FOV: 45 degrees, color fundus image.
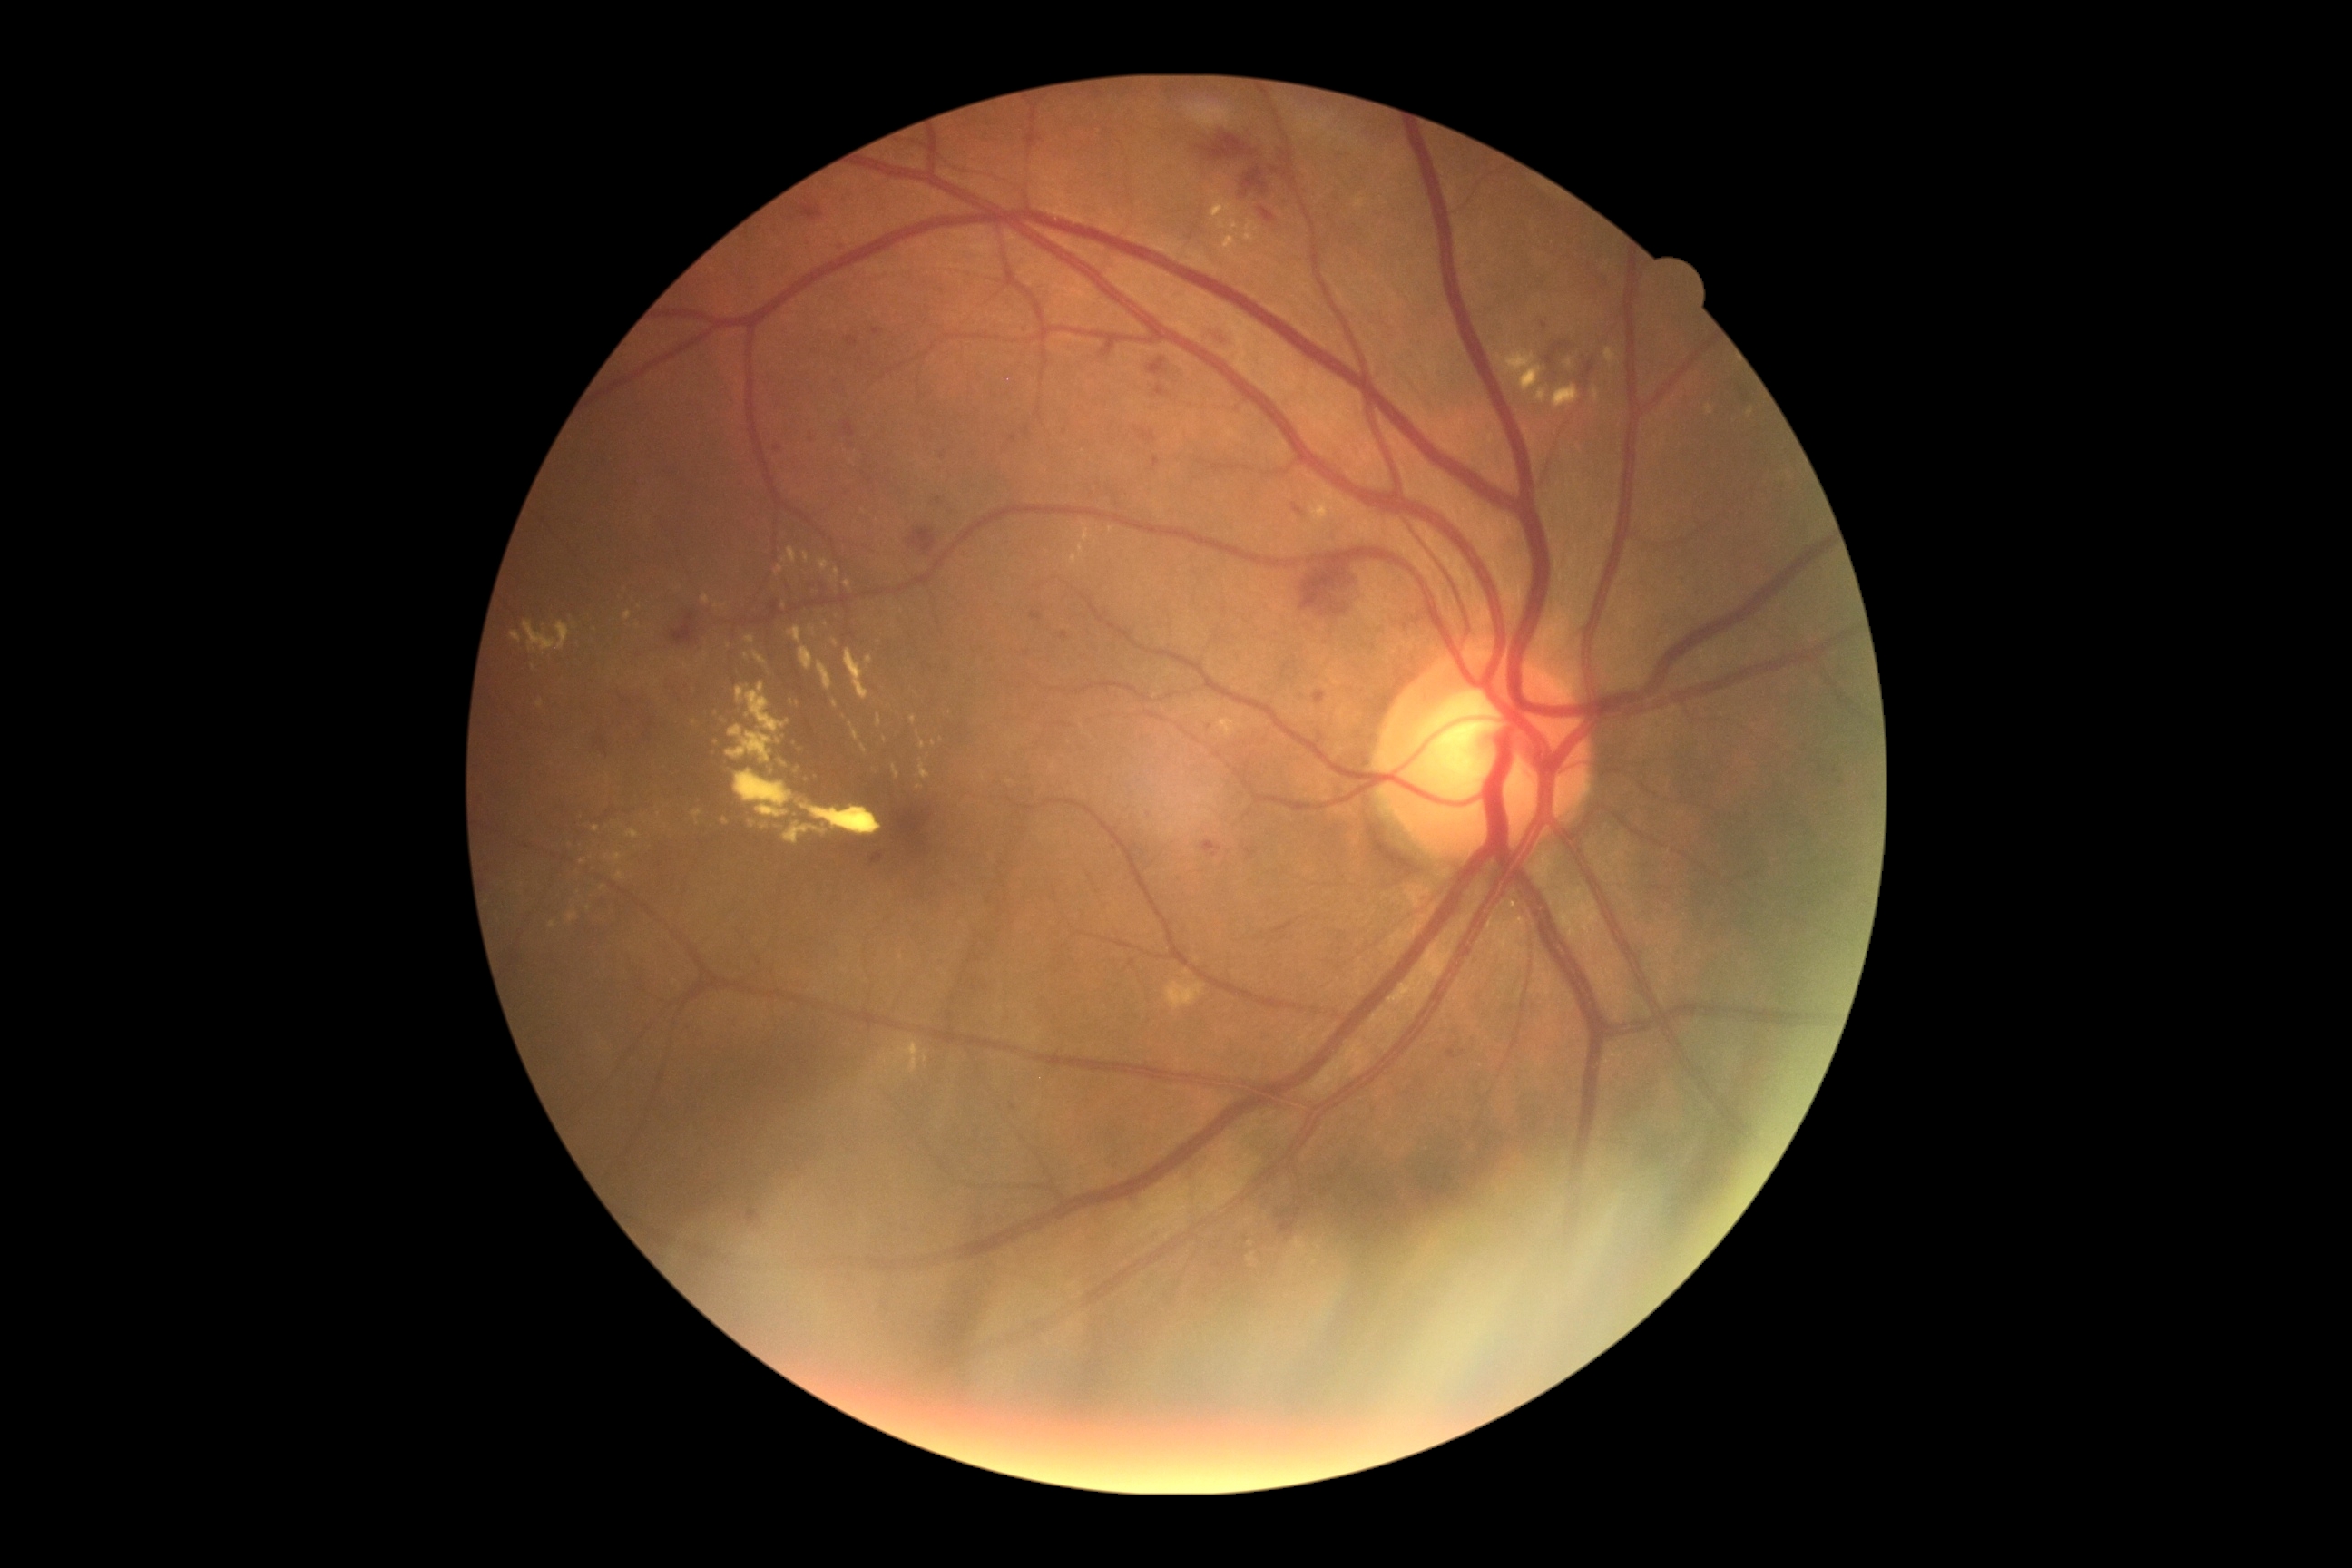 <lesions partial="true">
  <dr_grade>2</dr_grade>
  <se />
  <he partial="true">l=908, t=529, r=937, b=554, l=1135, t=429, r=1157, b=444, l=1277, t=1211, r=1286, b=1219, l=1280, t=1220, r=1297, b=1233, l=671, t=614, r=696, b=647, l=772, t=602, r=783, b=618, l=1295, t=560, r=1357, b=616, l=747, t=1210, r=761, b=1222, l=1208, t=331, r=1235, b=346, l=847, t=440, r=854, b=451, l=1293, t=505, r=1304, b=516, l=1202, t=841, r=1222, b=859, l=1155, t=387, r=1170, b=397</he>
  <he_small_centers>(x=1283, y=155)</he_small_centers>
  <ex partial="true">l=569, t=912, r=578, b=923, l=734, t=769, r=794, b=819, l=745, t=636, r=754, b=643, l=691, t=681, r=698, b=694, l=803, t=553, r=810, b=564, l=919, t=763, r=930, b=779, l=799, t=647, r=814, b=671, l=783, t=547, r=796, b=565, l=845, t=649, r=870, b=701, l=625, t=830, r=640, b=839, l=877, t=716, r=883, b=727, l=770, t=769, r=776, b=778</ex>
  <ex_small_centers>(x=695, y=724), (x=765, y=827), (x=1111, y=530), (x=845, y=718), (x=685, y=667), (x=597, y=830)</ex_small_centers>
  <ma partial="true">l=874, t=328, r=883, b=335, l=1063, t=632, r=1068, b=640, l=838, t=244, r=845, b=253, l=1024, t=427, r=1030, b=436, l=1153, t=456, r=1161, b=469, l=1155, t=391, r=1164, b=398, l=1447, t=1052, r=1455, b=1055</ma>
  <ma_small_centers>(x=943, y=456), (x=939, y=501), (x=777, y=450), (x=734, y=403), (x=1115, y=848), (x=1013, y=1107), (x=1024, y=327), (x=1544, y=325), (x=1015, y=438), (x=812, y=440), (x=741, y=482)</ma_small_centers>
</lesions>